Acquired with a NIDEK AFC-230. Nonmydriatic fundus photograph
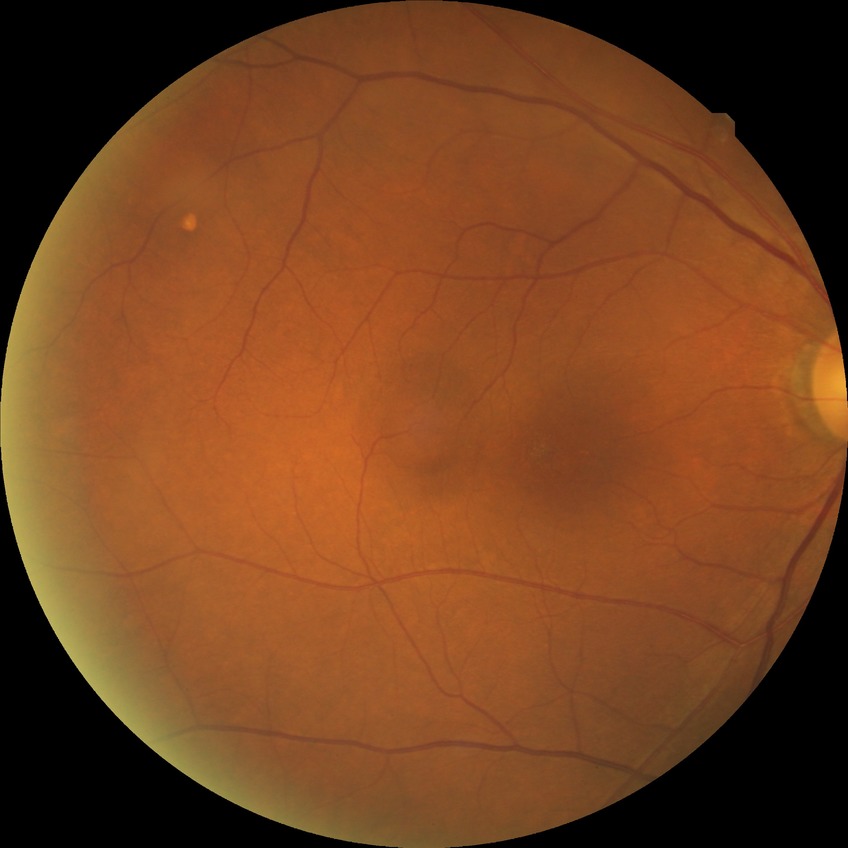 {"dr_impression": "no DR findings", "davis_grade": "NDR"}